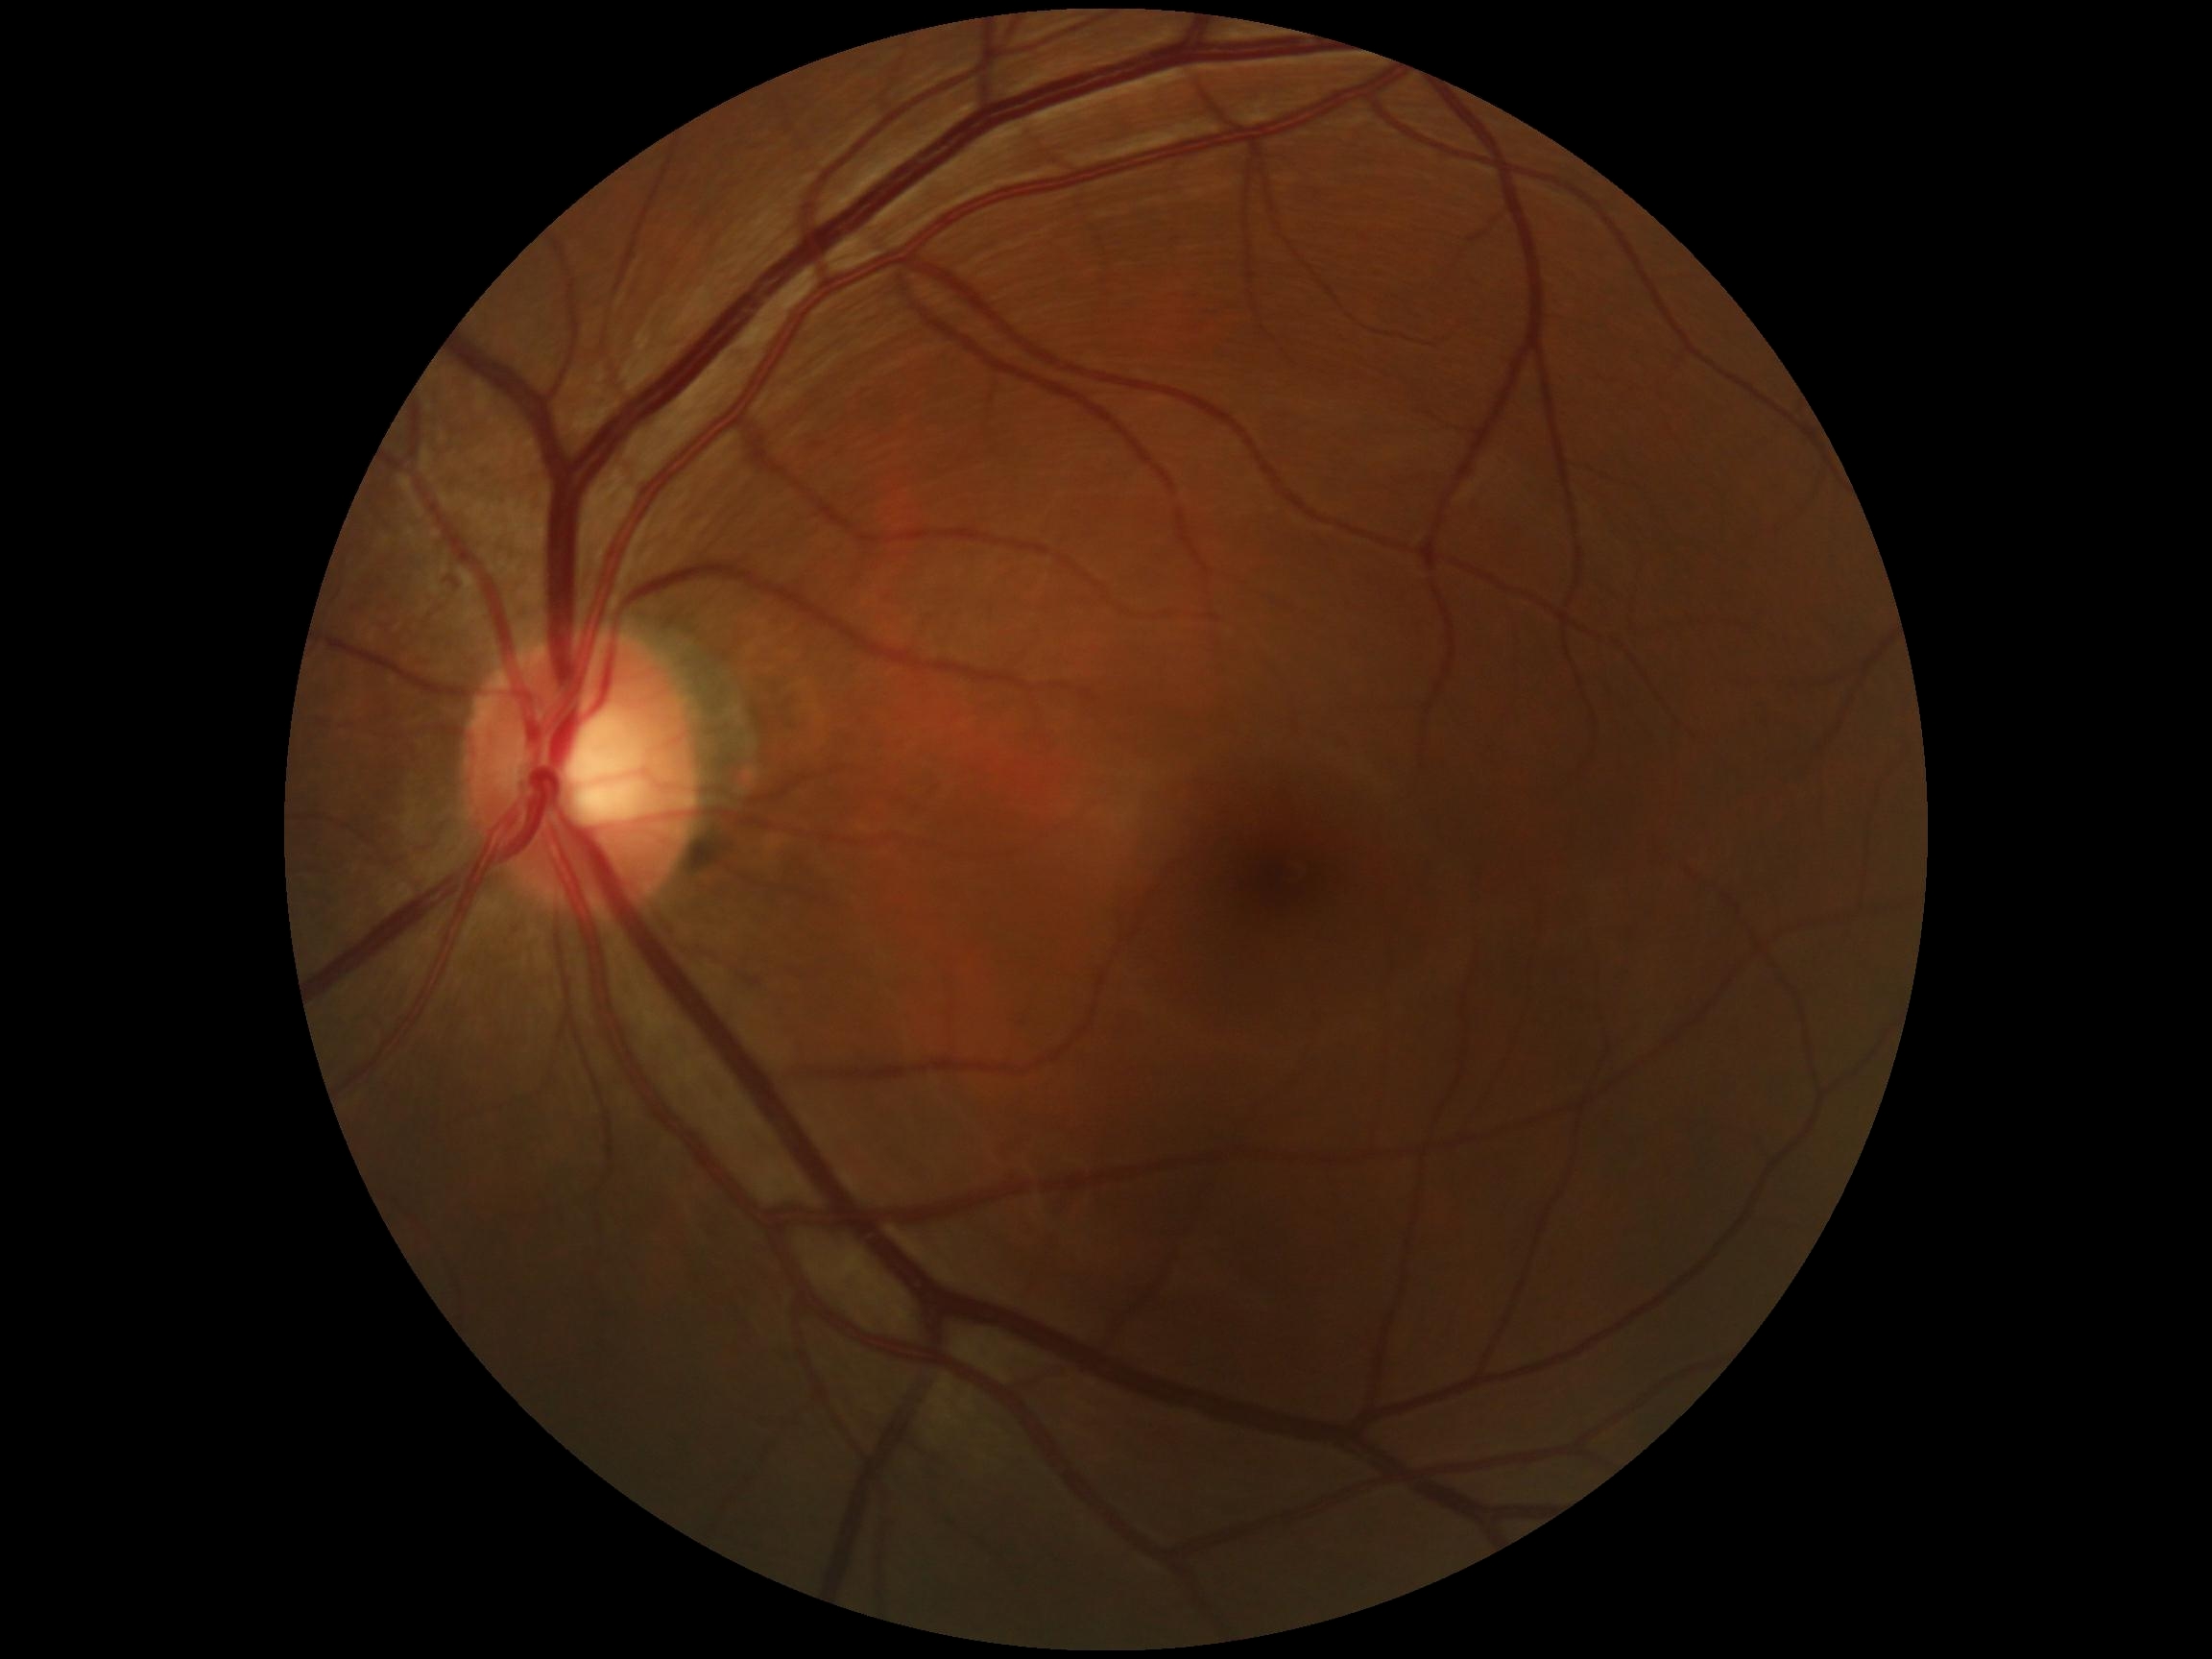
DR is grade 0 (no apparent retinopathy).